45-degree field of view
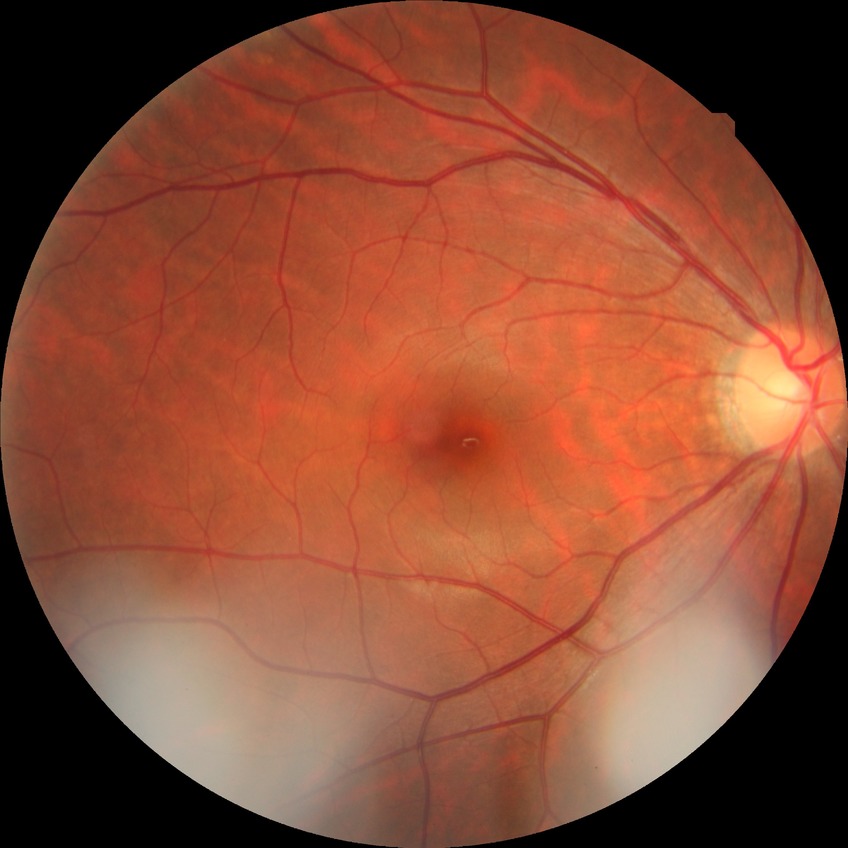
Davis stage = NDR.